Acquired on the Phoenix ICON · pediatric wide-field fundus photograph:
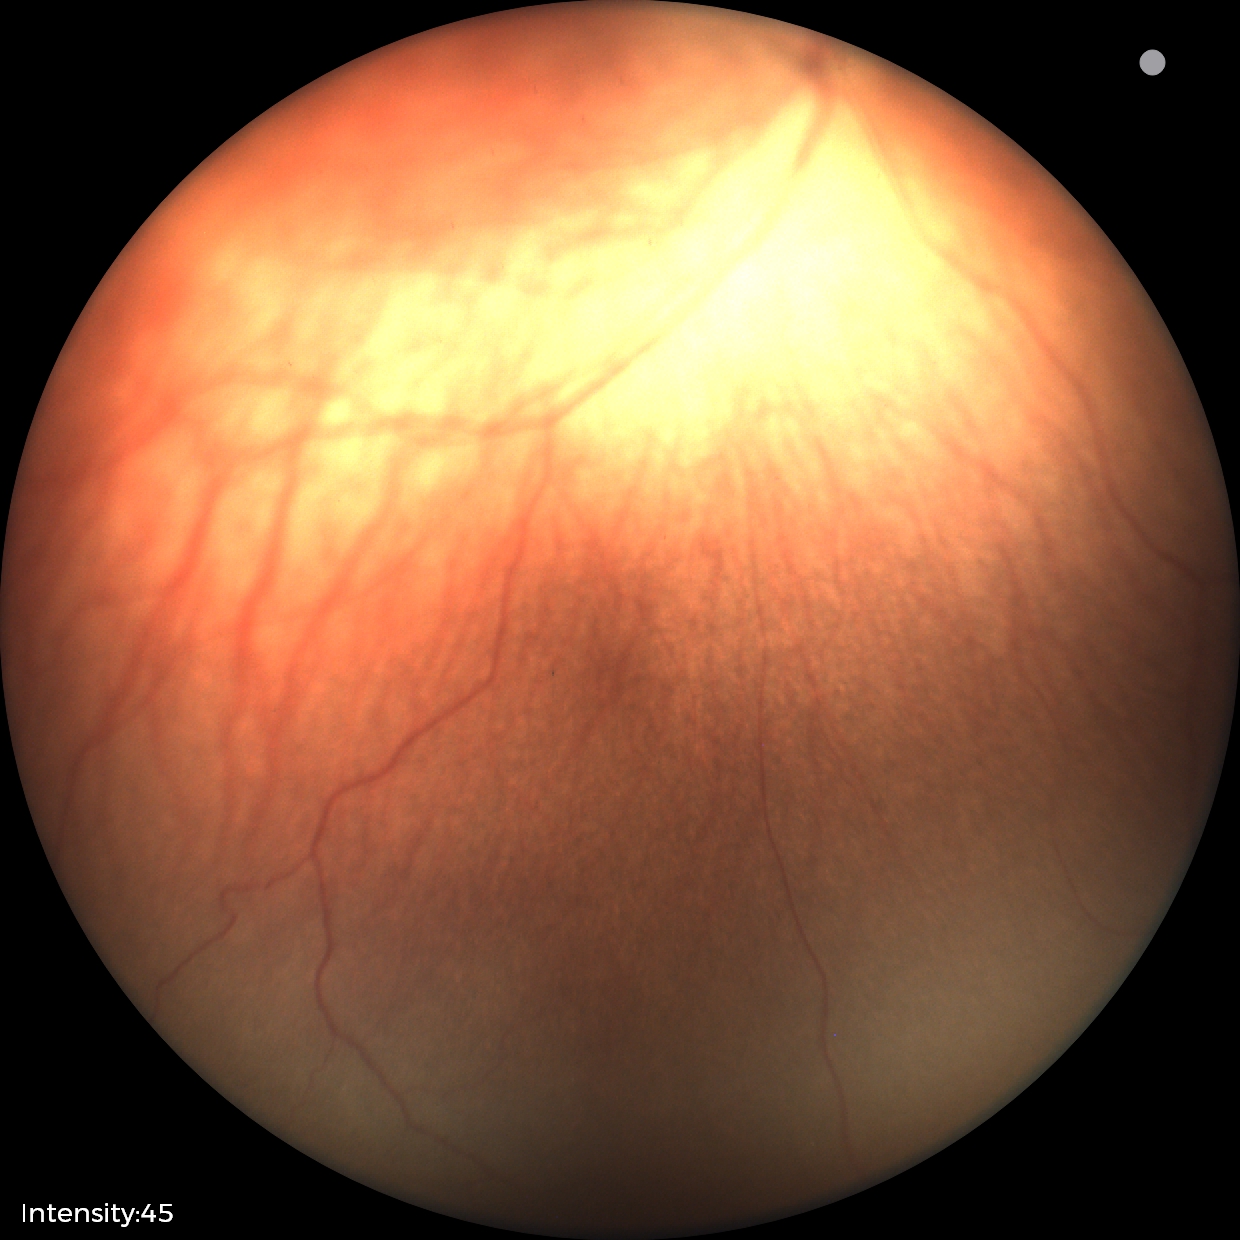 ROP diagnosis: stage 1 — demarcation line between vascular and avascular retina; plus disease: absent — posterior pole vessels without abnormal dilation or tortuosity.